50-degree field of view — 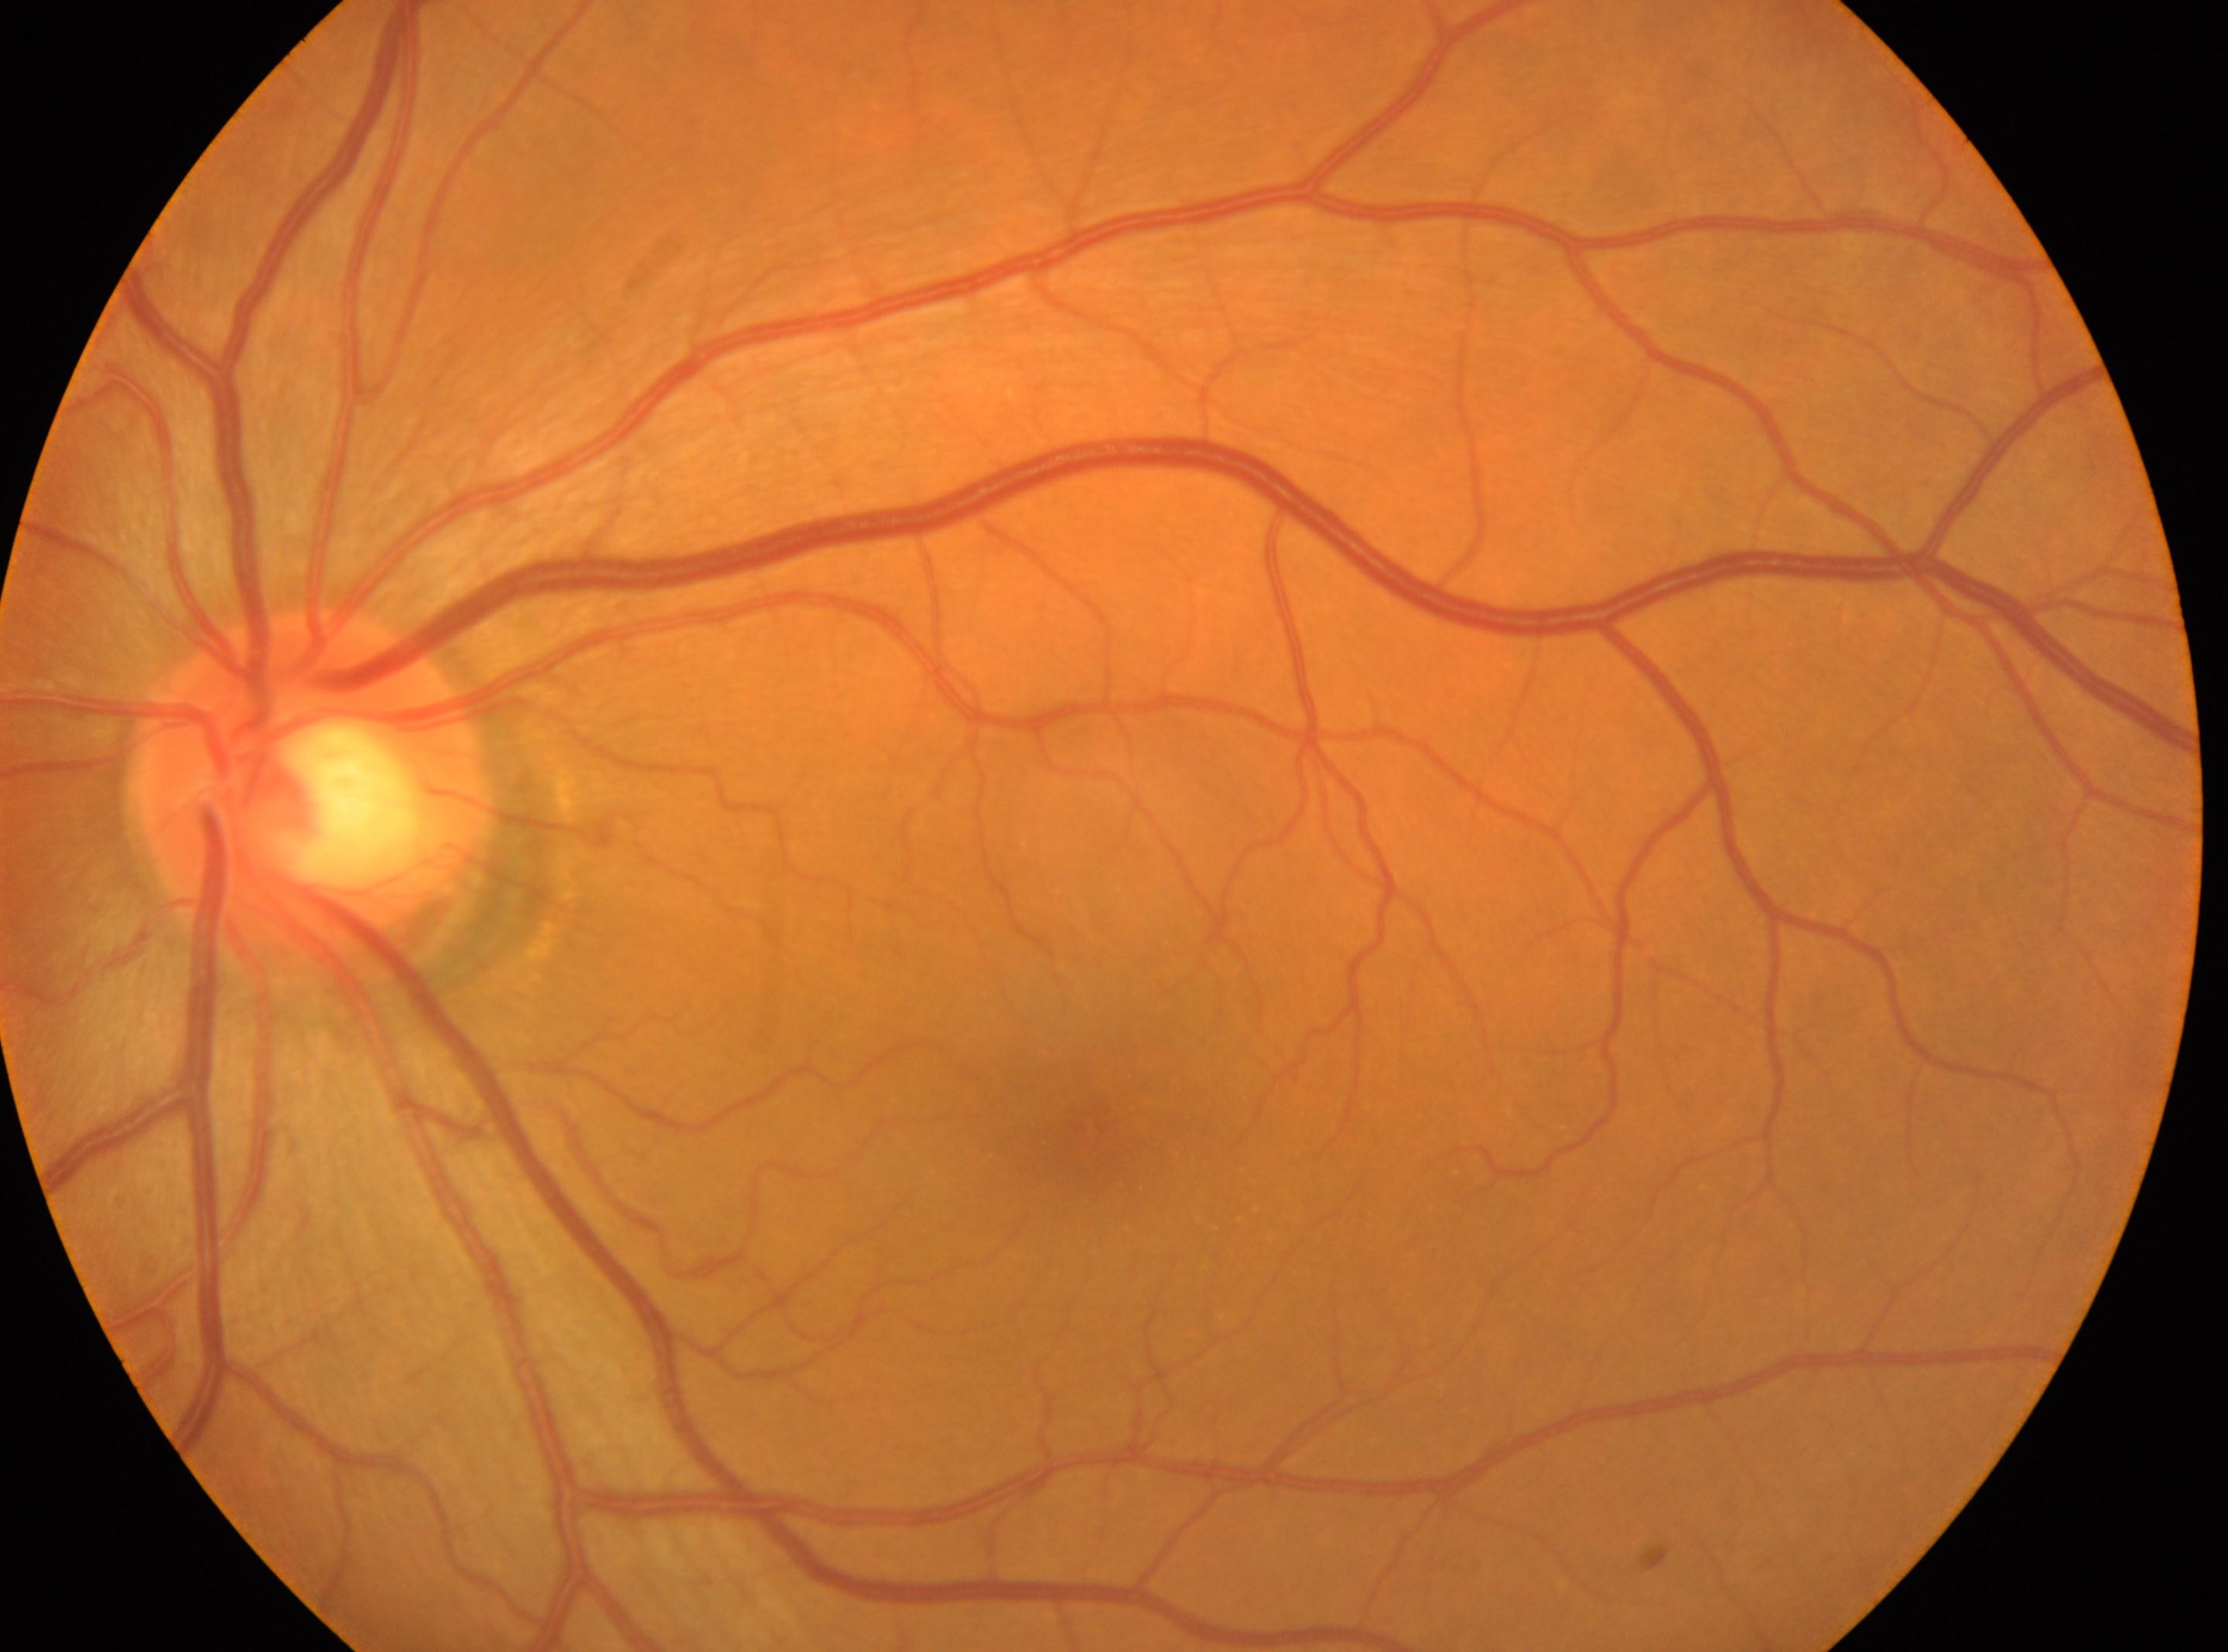 Eye: the left eye.
Fovea: (1091,1131).
No diabetic retinopathy identified.
DR: no apparent diabetic retinopathy (grade 0).
The optic disc center is at (307,785).